45° field of view
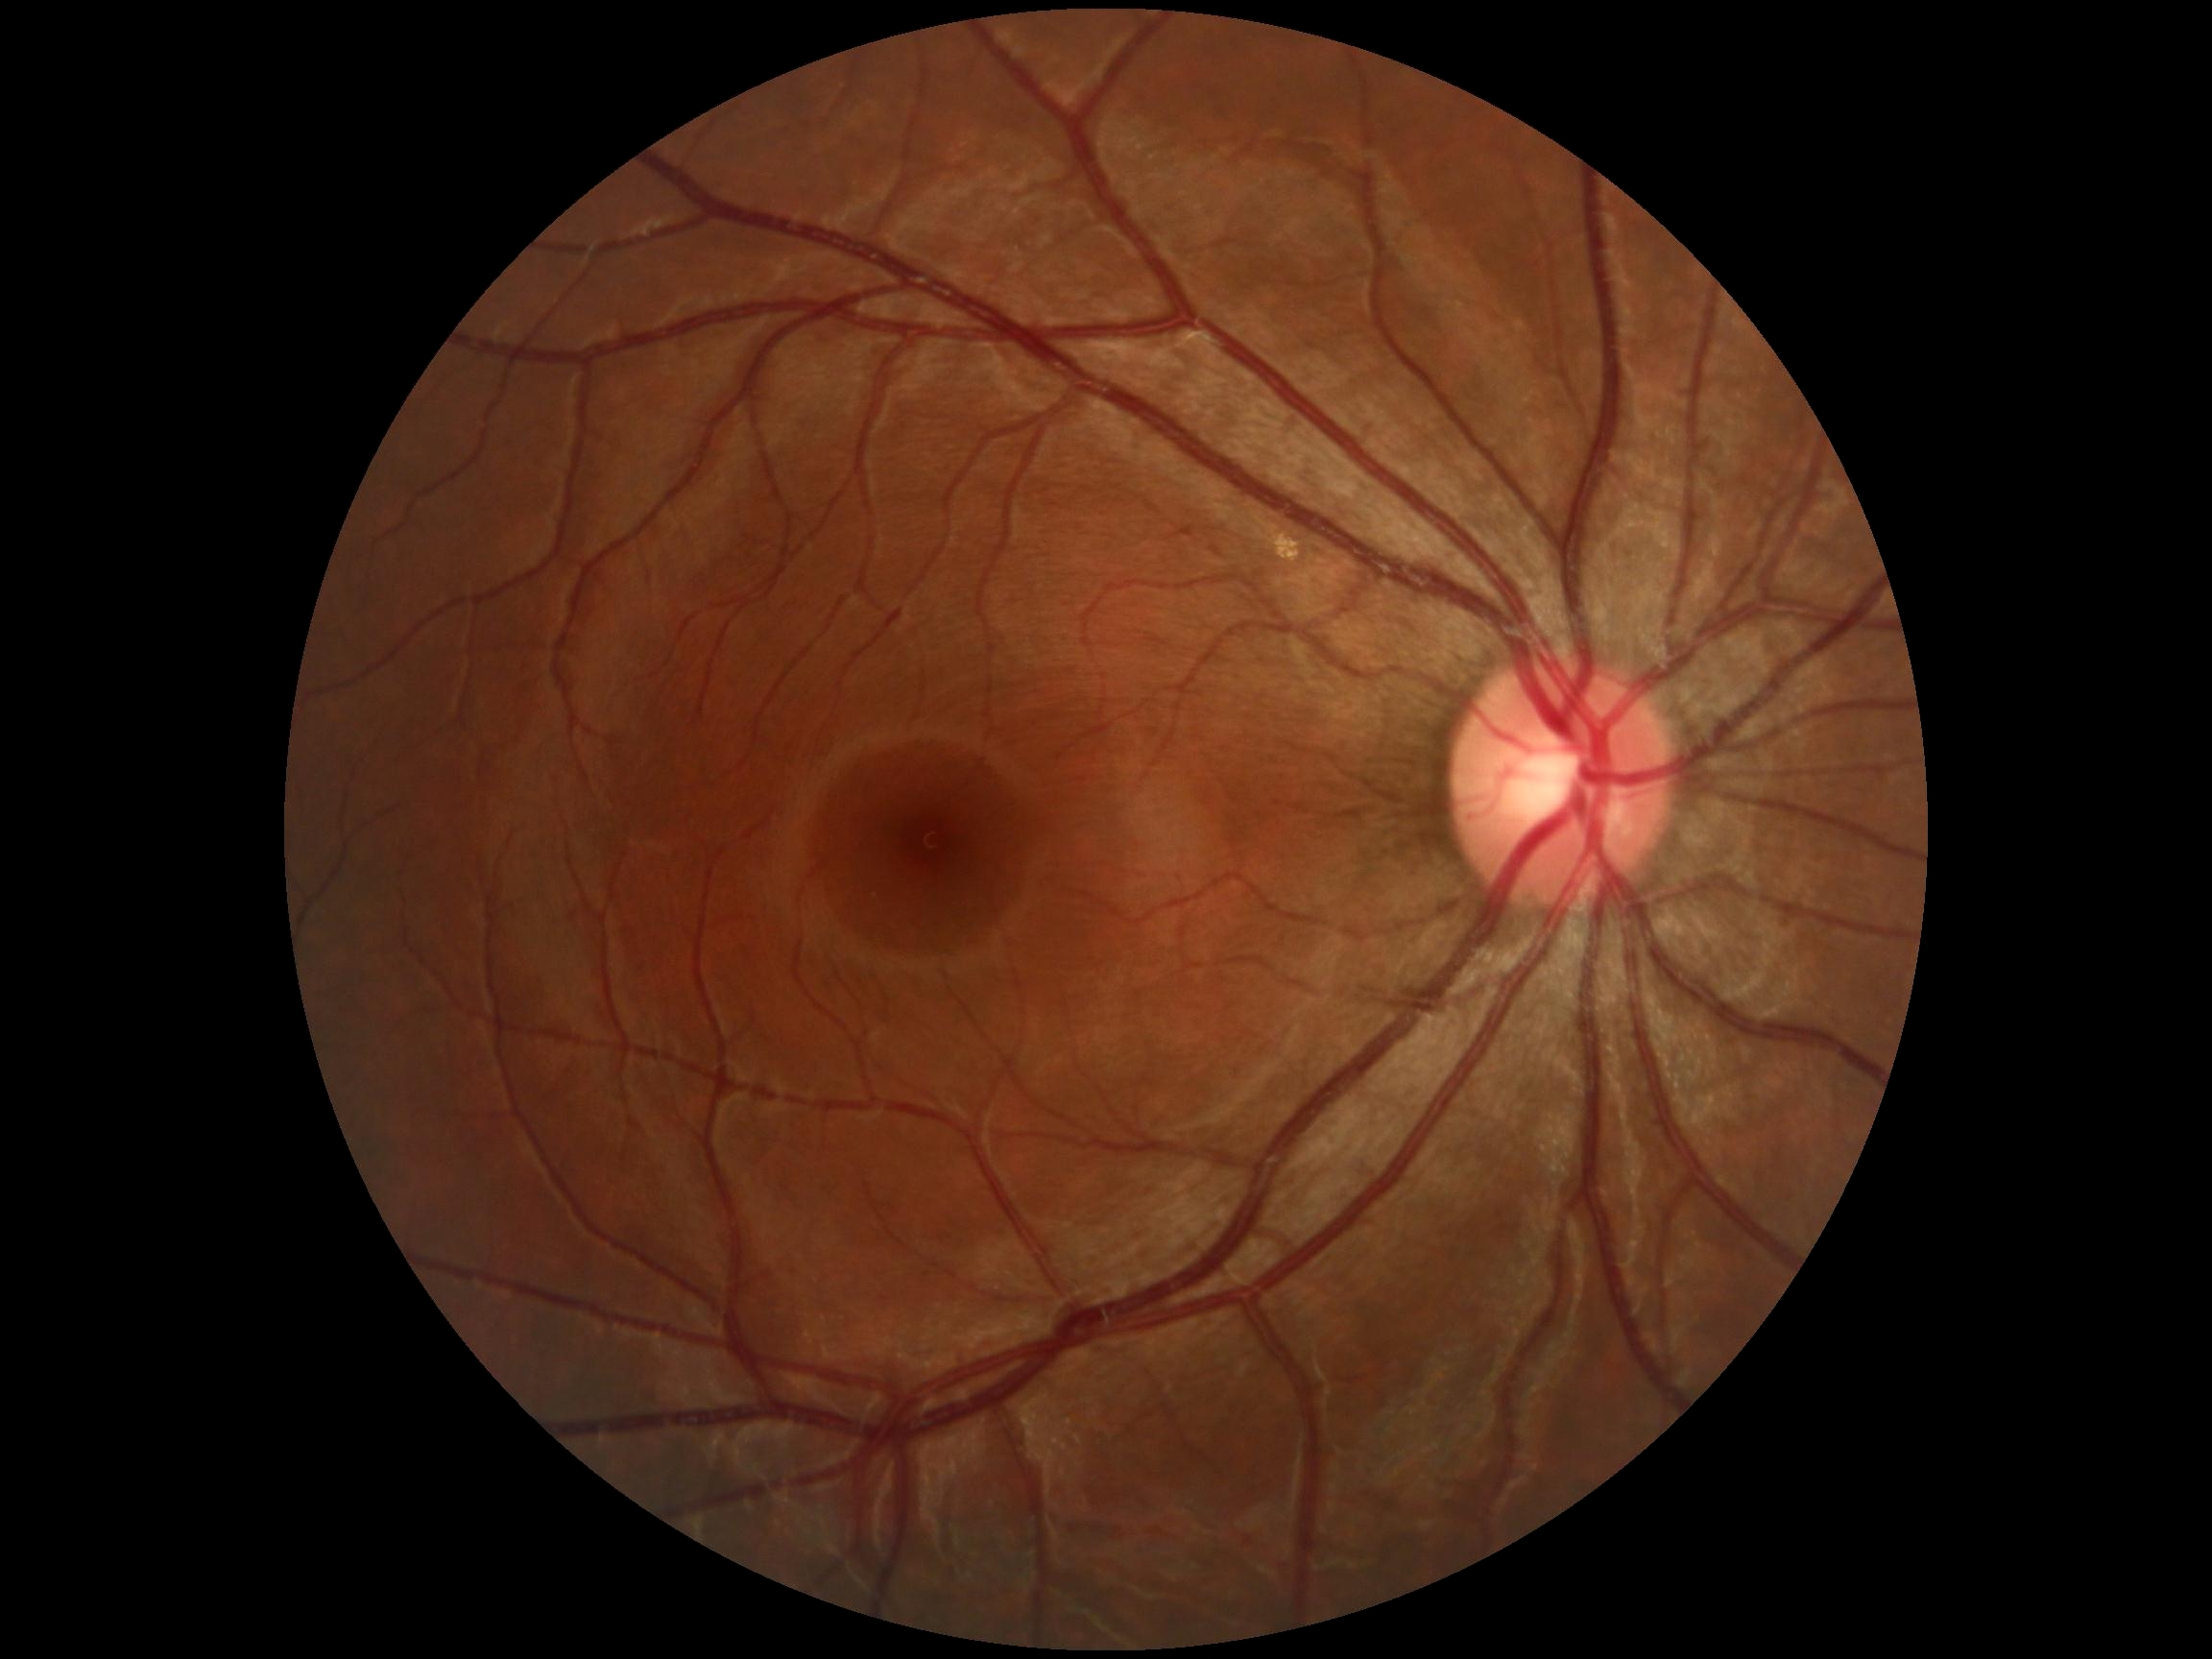 DR severity is no apparent retinopathy (grade 0).